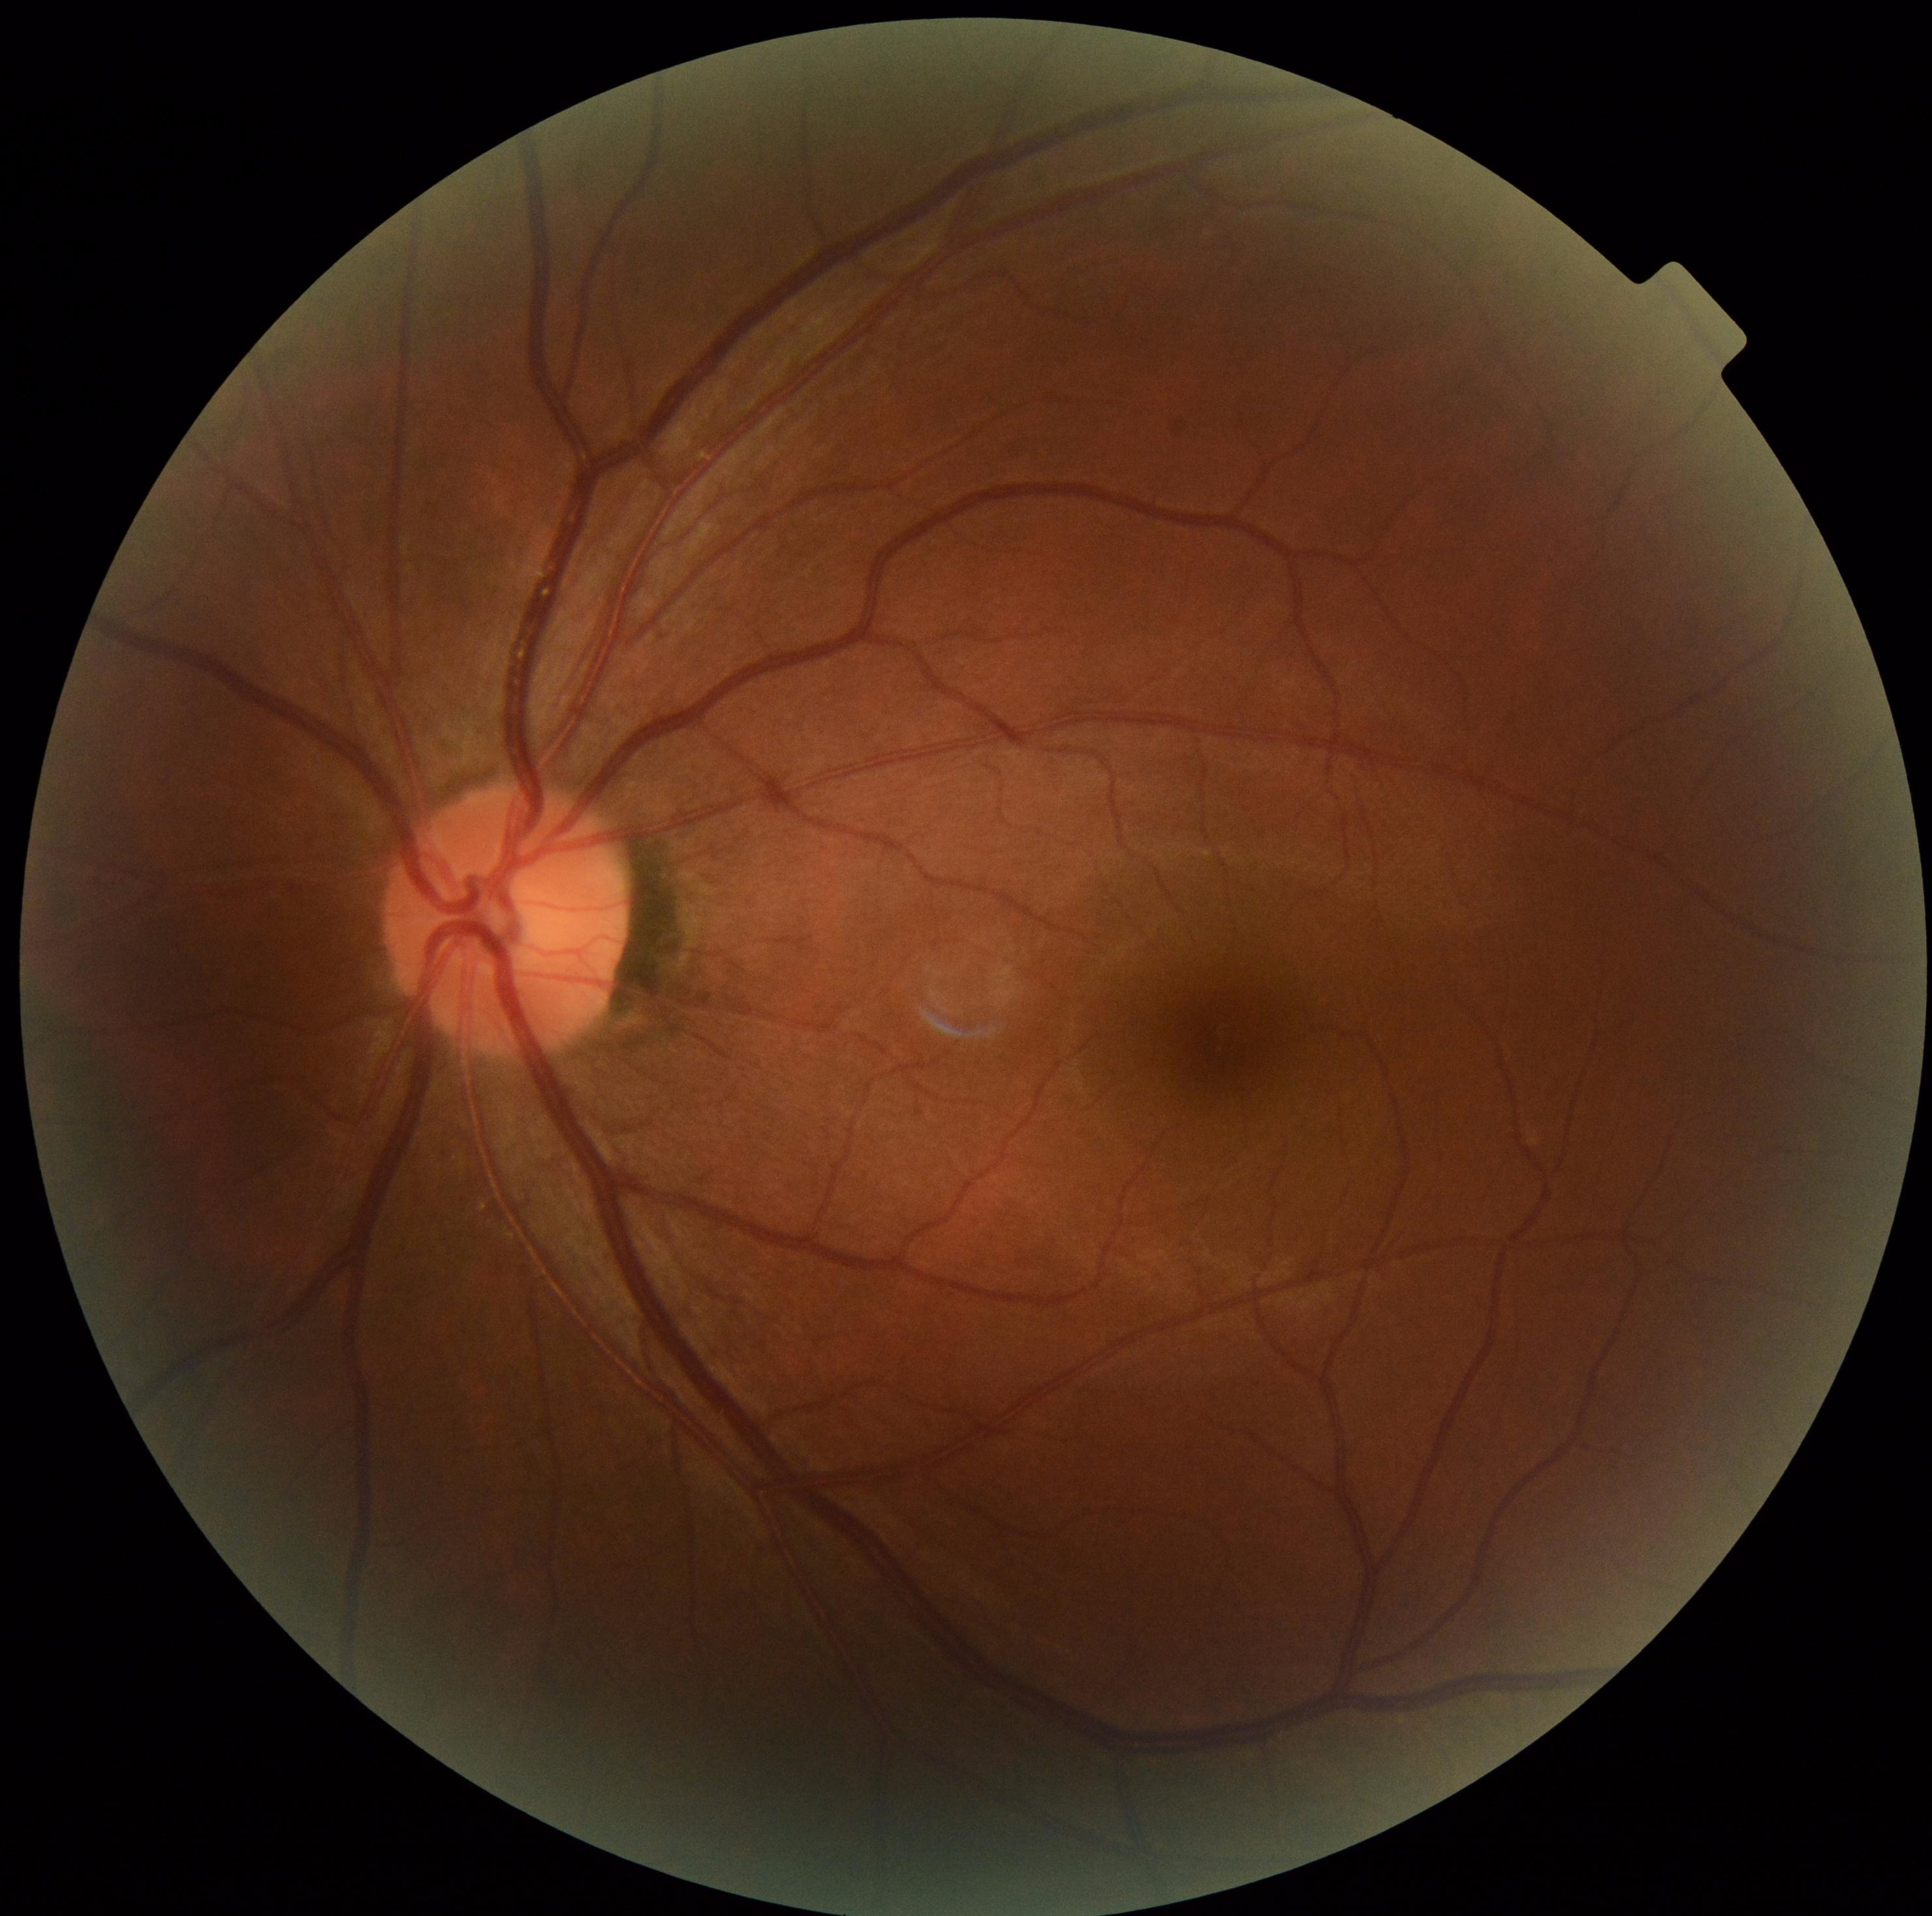 Findings:
* diabetic retinopathy (DR): grade 0 (no apparent retinopathy)
* DR impression: negative for DR